CFP
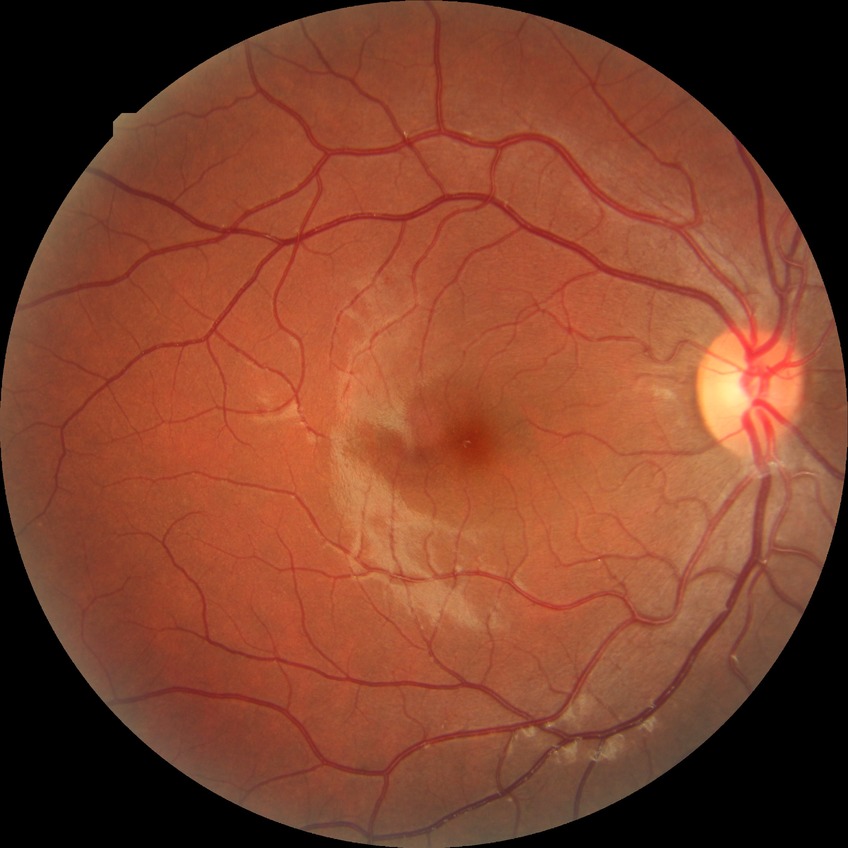

Davis DR grade: NDR; DR impression: no signs of DR.